Retinal fundus photograph · FOV: 45 degrees: 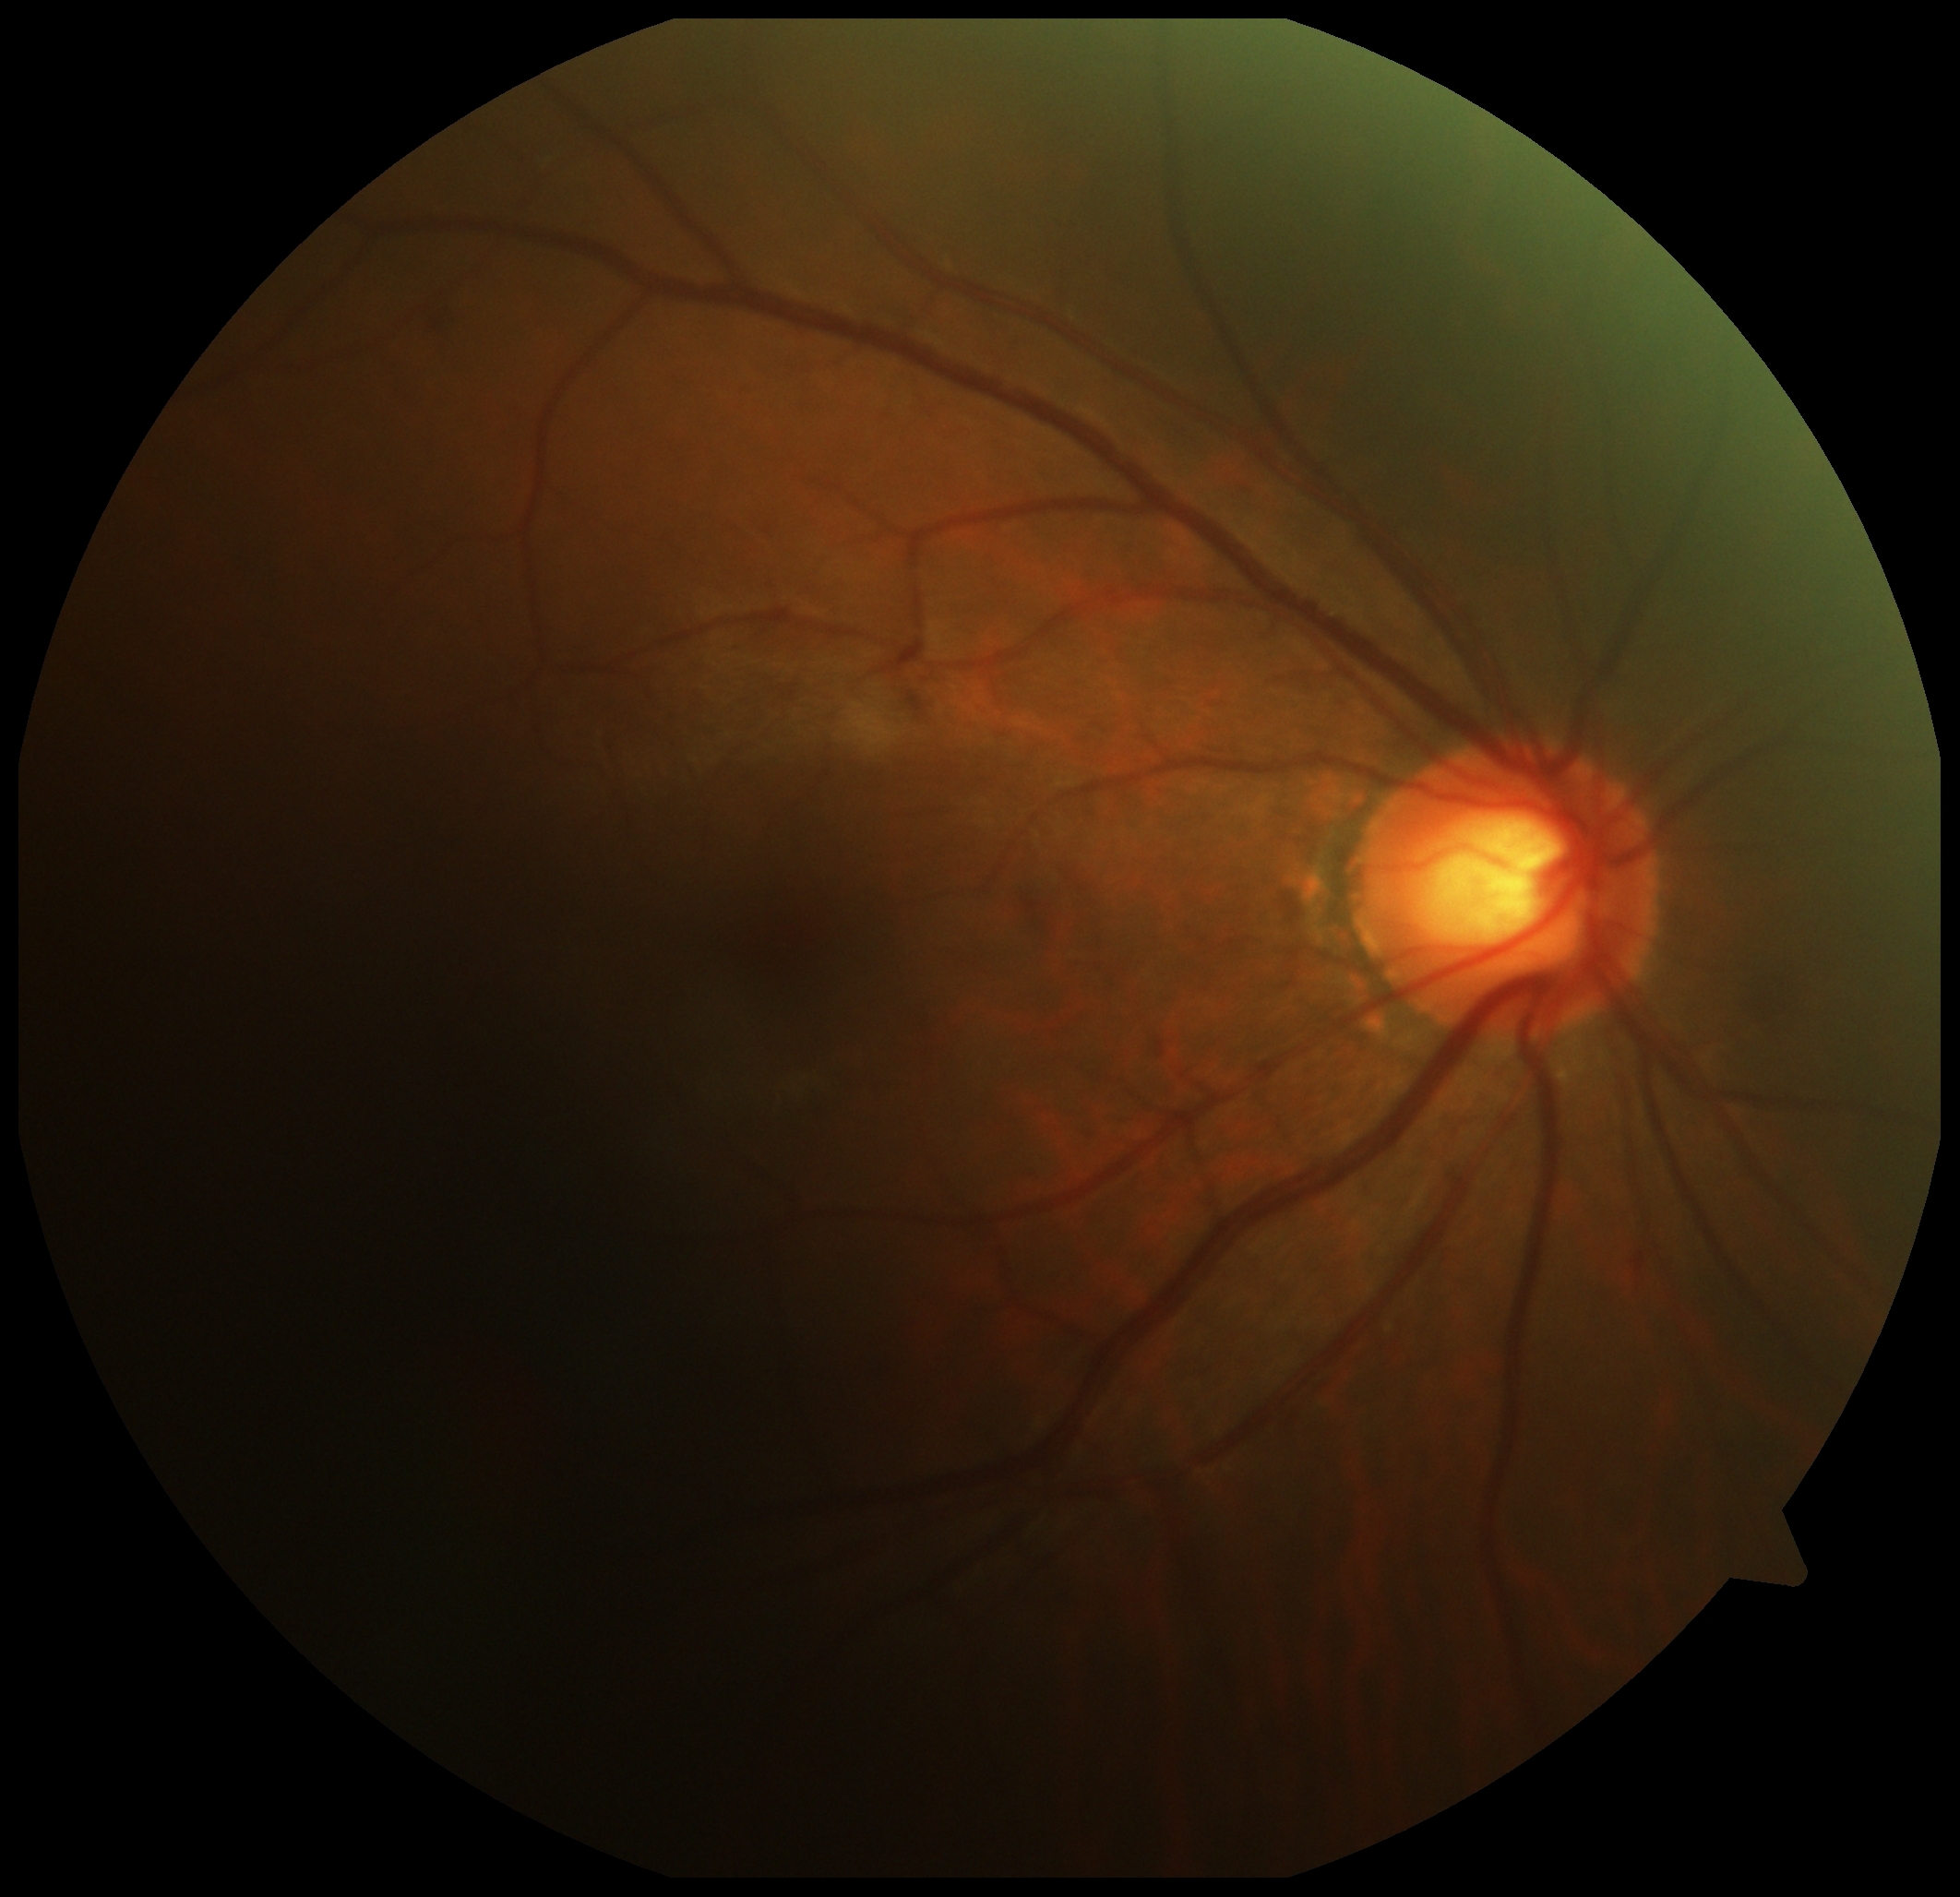
Diabetic retinopathy is moderate non-proliferative diabetic retinopathy (grade 2).
DR class: non-proliferative diabetic retinopathy.